2212x1659px:
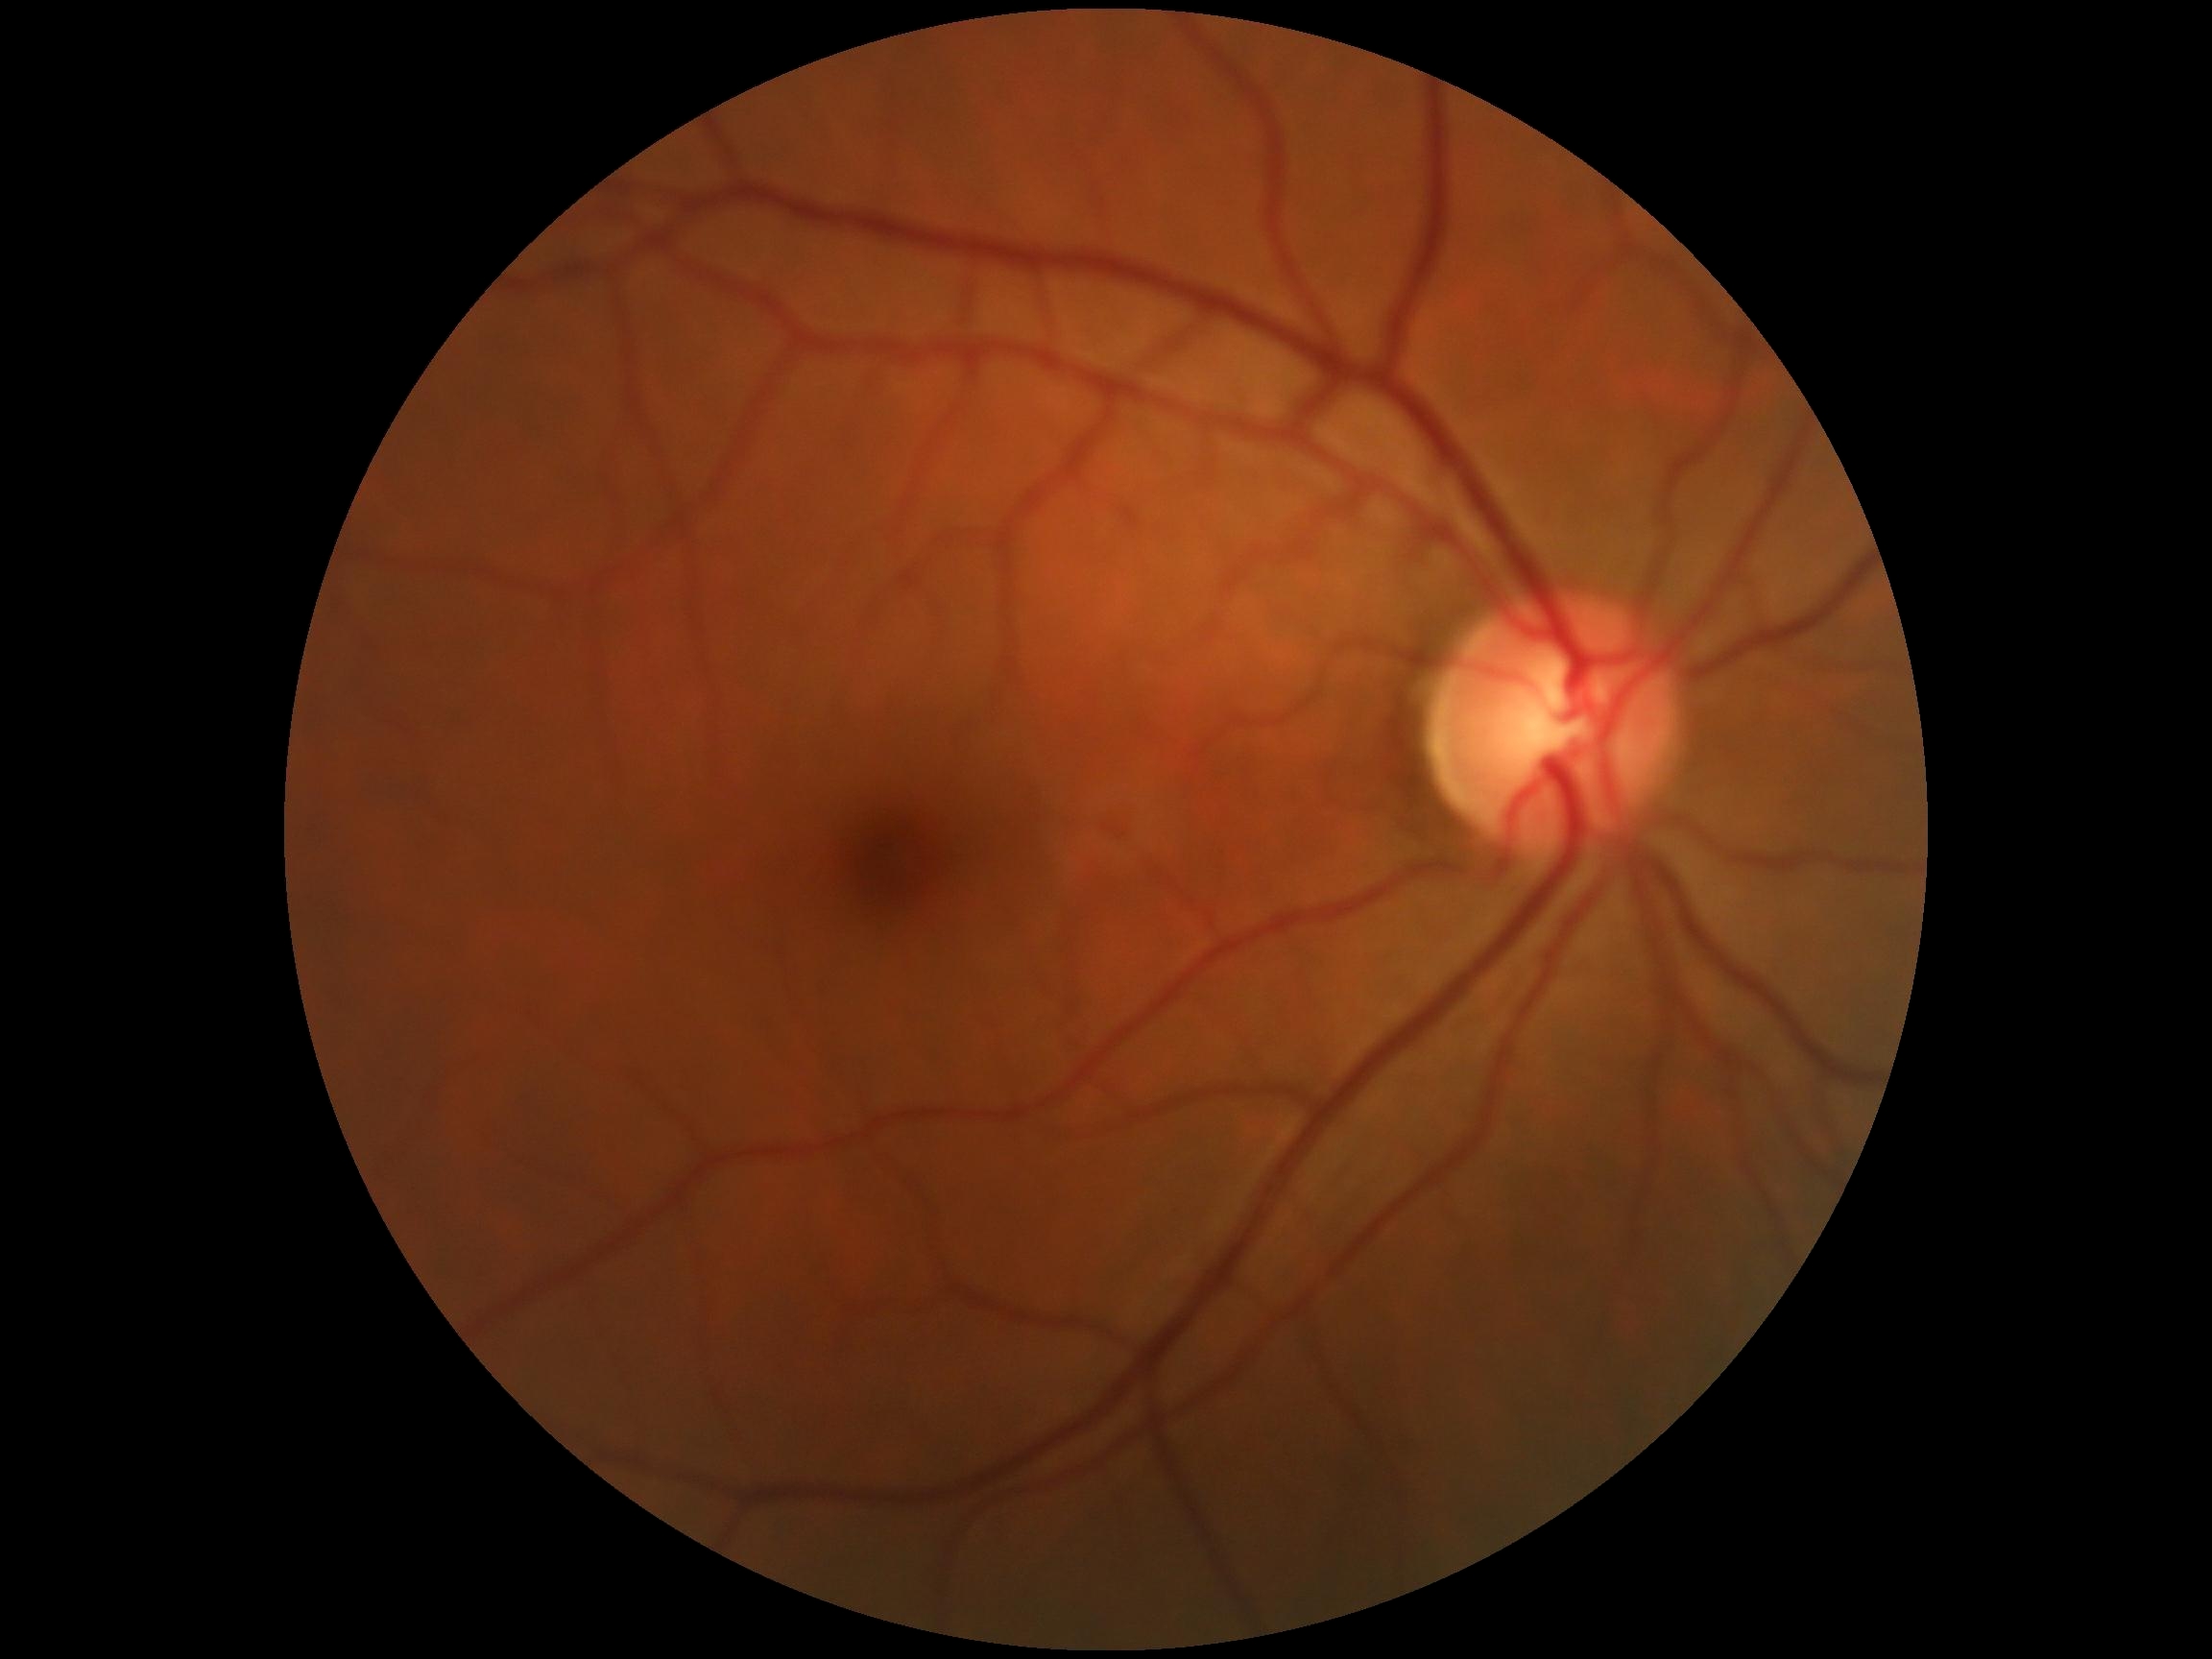

dr_grade: grade 0